Retinal fundus photograph, Davis DR grading:
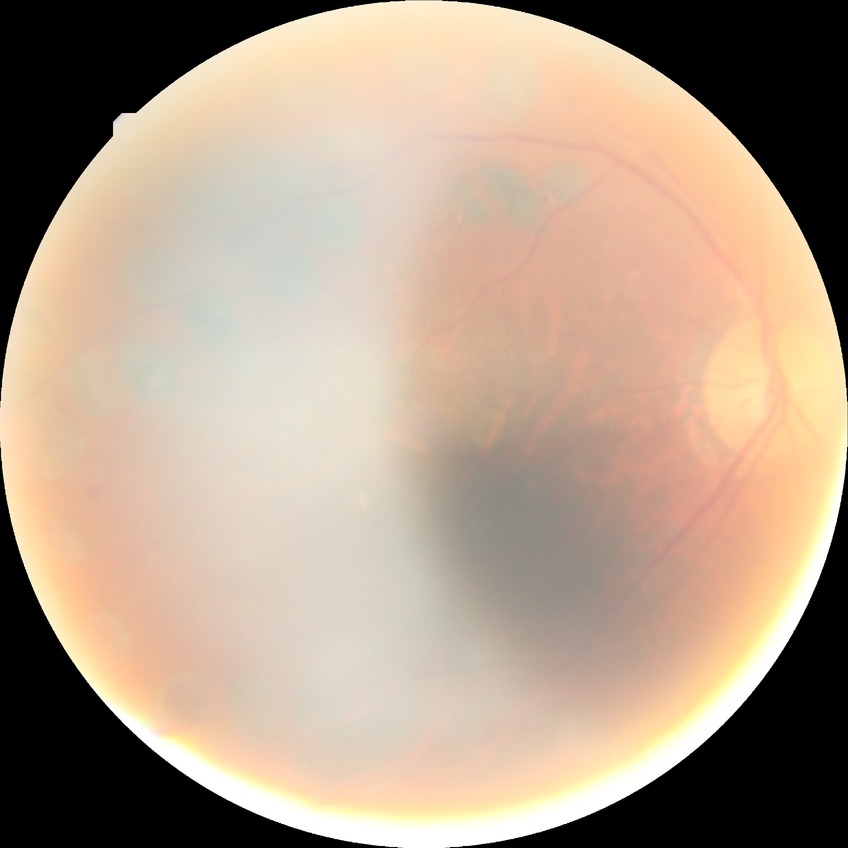 Annotations:
• diabetic retinopathy (DR) — proliferative diabetic retinopathy (PDR)